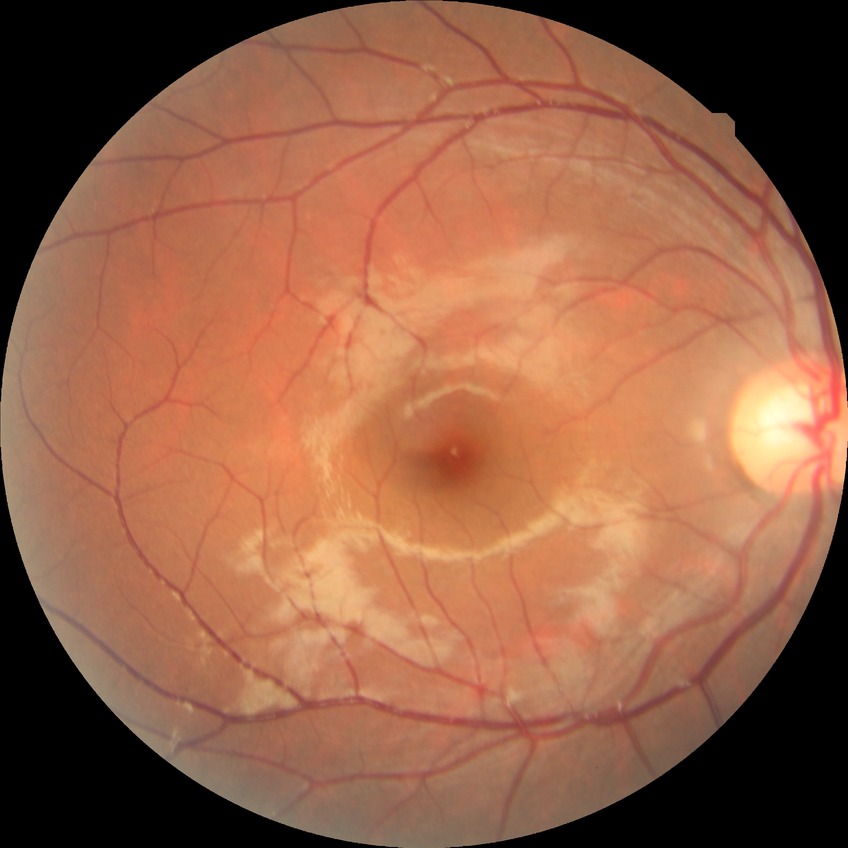
{"davis_grade": "no diabetic retinopathy (NDR)"}